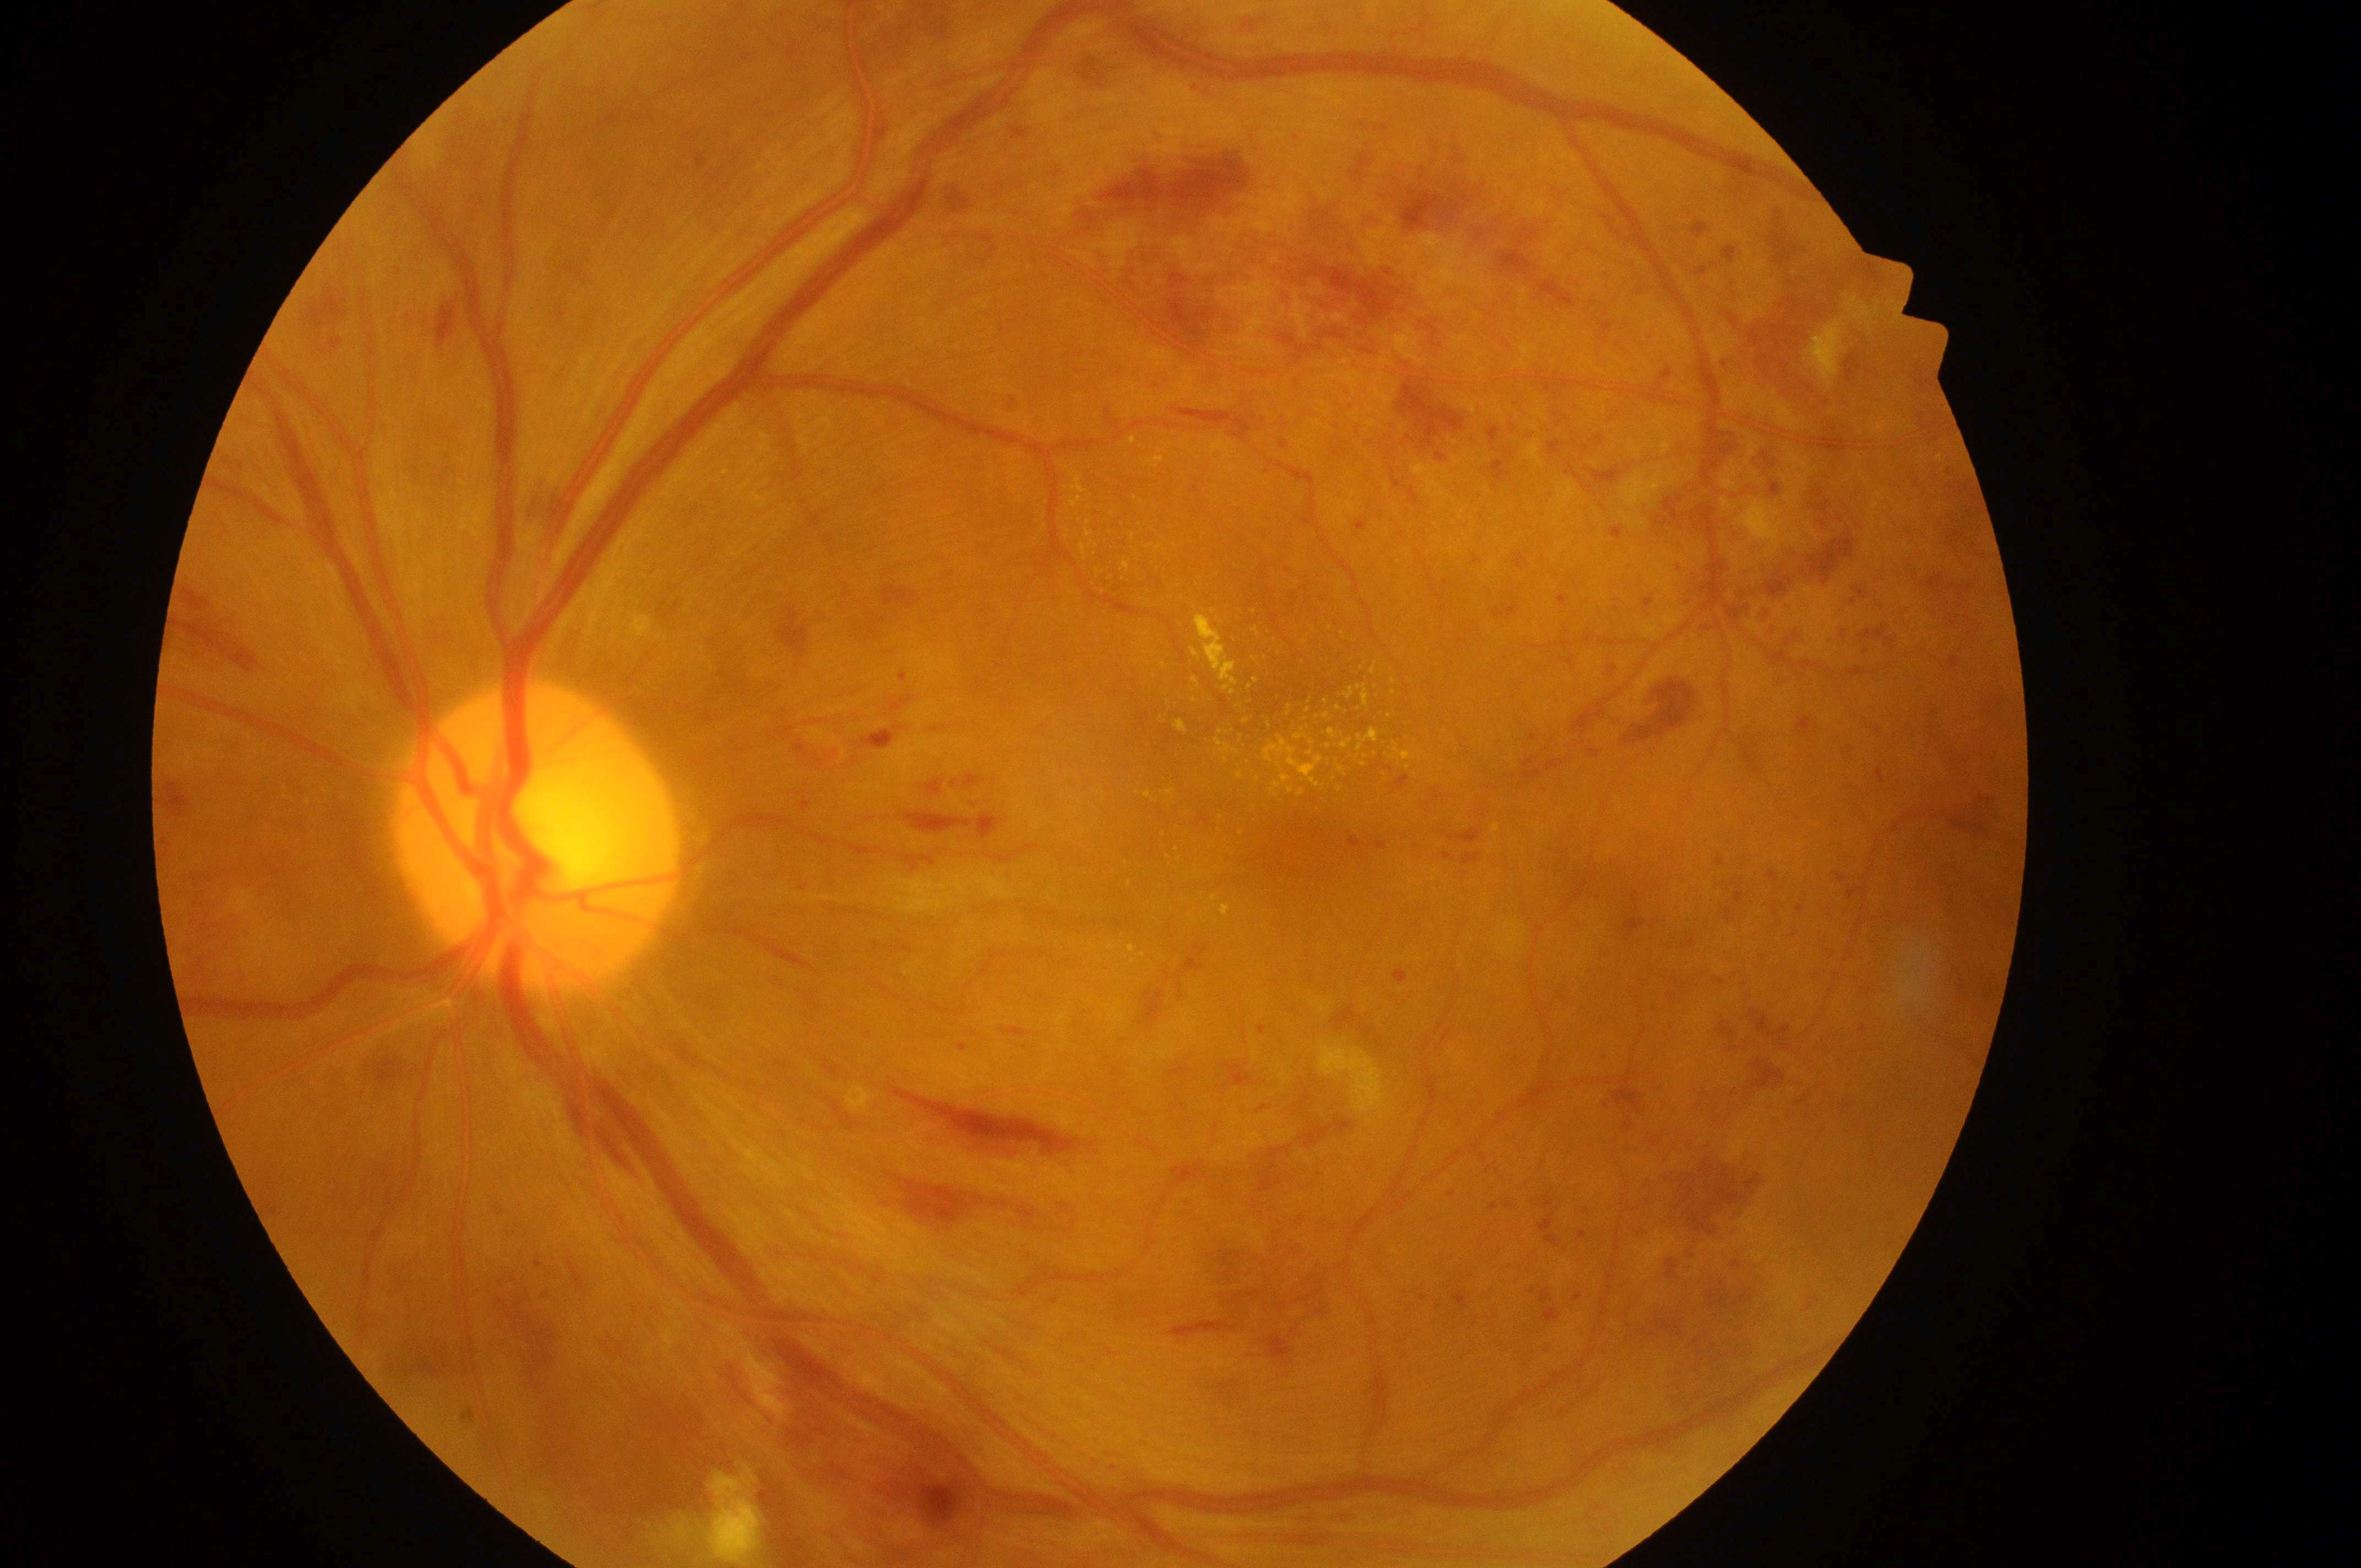

| feature | annotation |
|---|---|
| diabetic retinopathy (DR) | severe non-proliferative diabetic retinopathy (grade 3) |
| the optic disc | 530, 850 |
| diabetic macular edema (DME) | high risk (grade 2) |
| fovea center | 1303, 853 |
| laterality | left eye |